848x848. Color fundus photograph. Nonmydriatic fundus photograph. Modified Davis classification
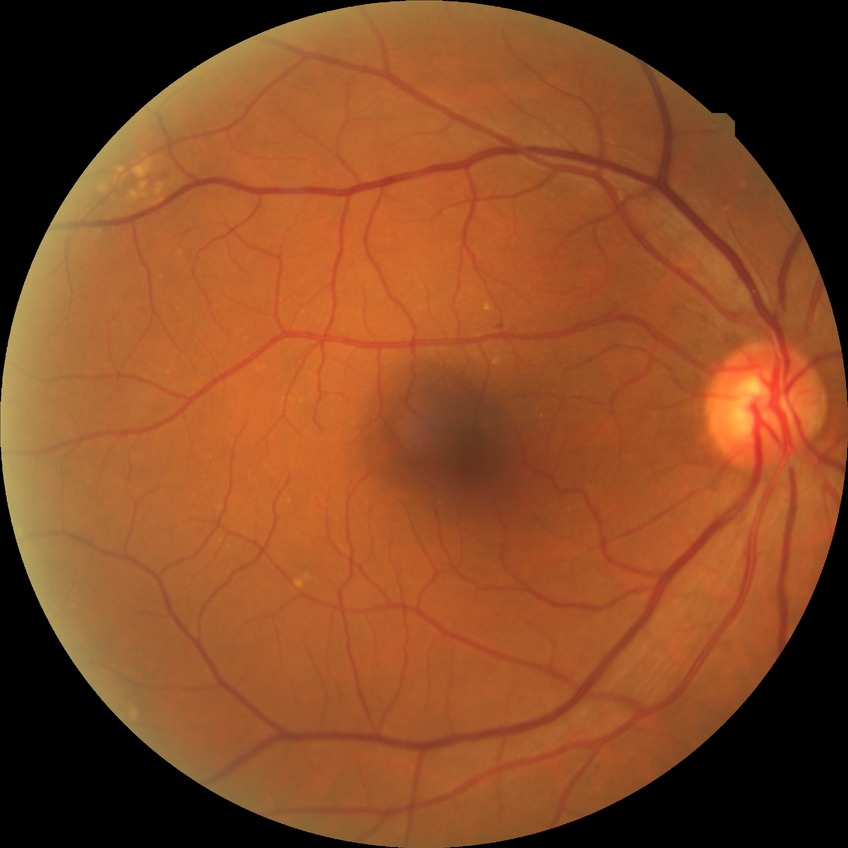
Modified Davis classification: no diabetic retinopathy.